1380 by 1382 pixels, color fundus image, 45° field of view: 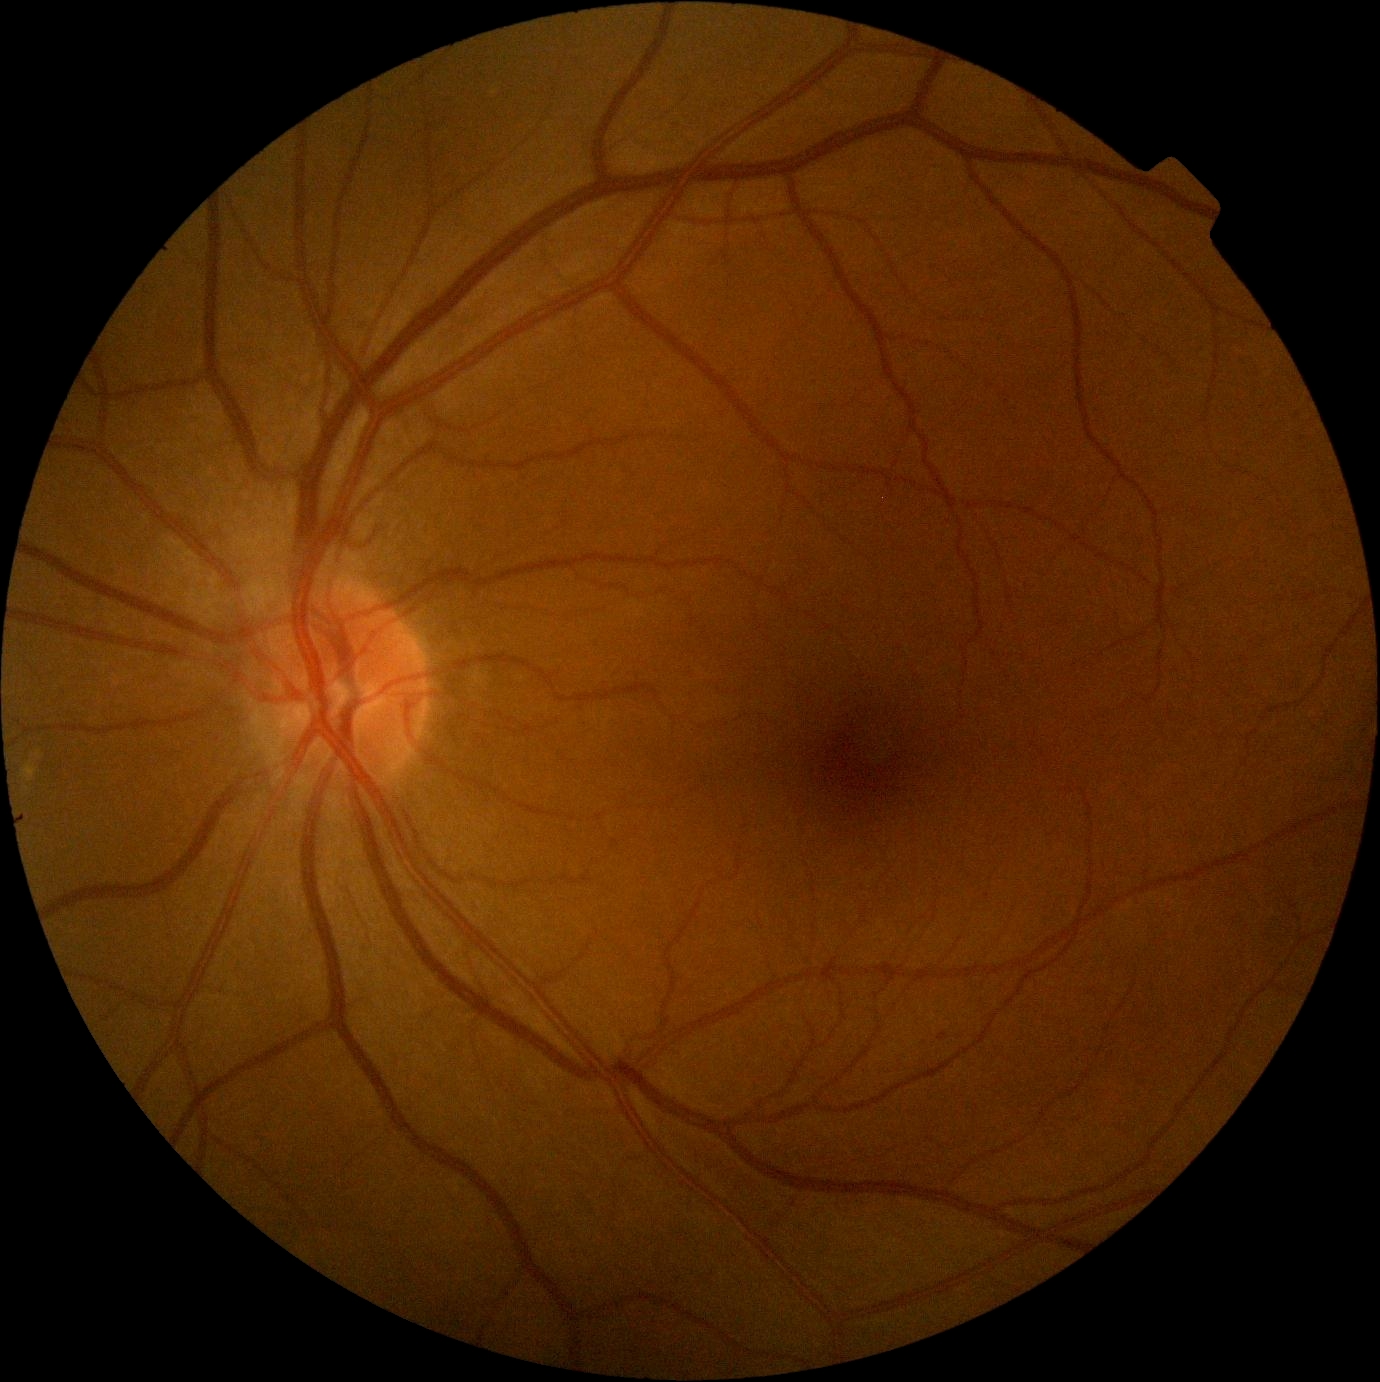 Diabetic retinopathy severity is no apparent retinopathy (grade 0). No diabetic retinal disease findings.